848x848px.
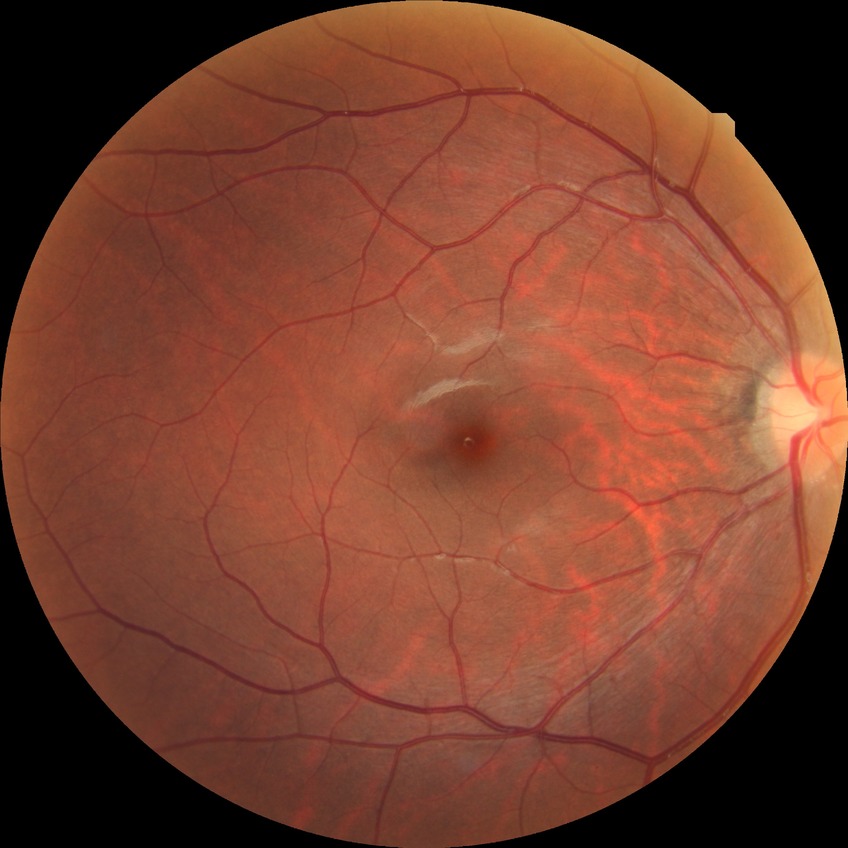 Retinopathy grade: no diabetic retinopathy.